640 x 480 pixels; wide-field fundus photograph of an infant.
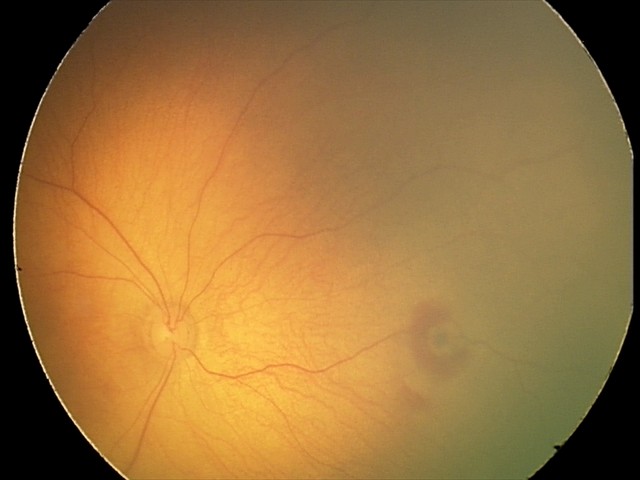
Examination diagnosed as retinal hemorrhages.